2352 x 1568 pixels: 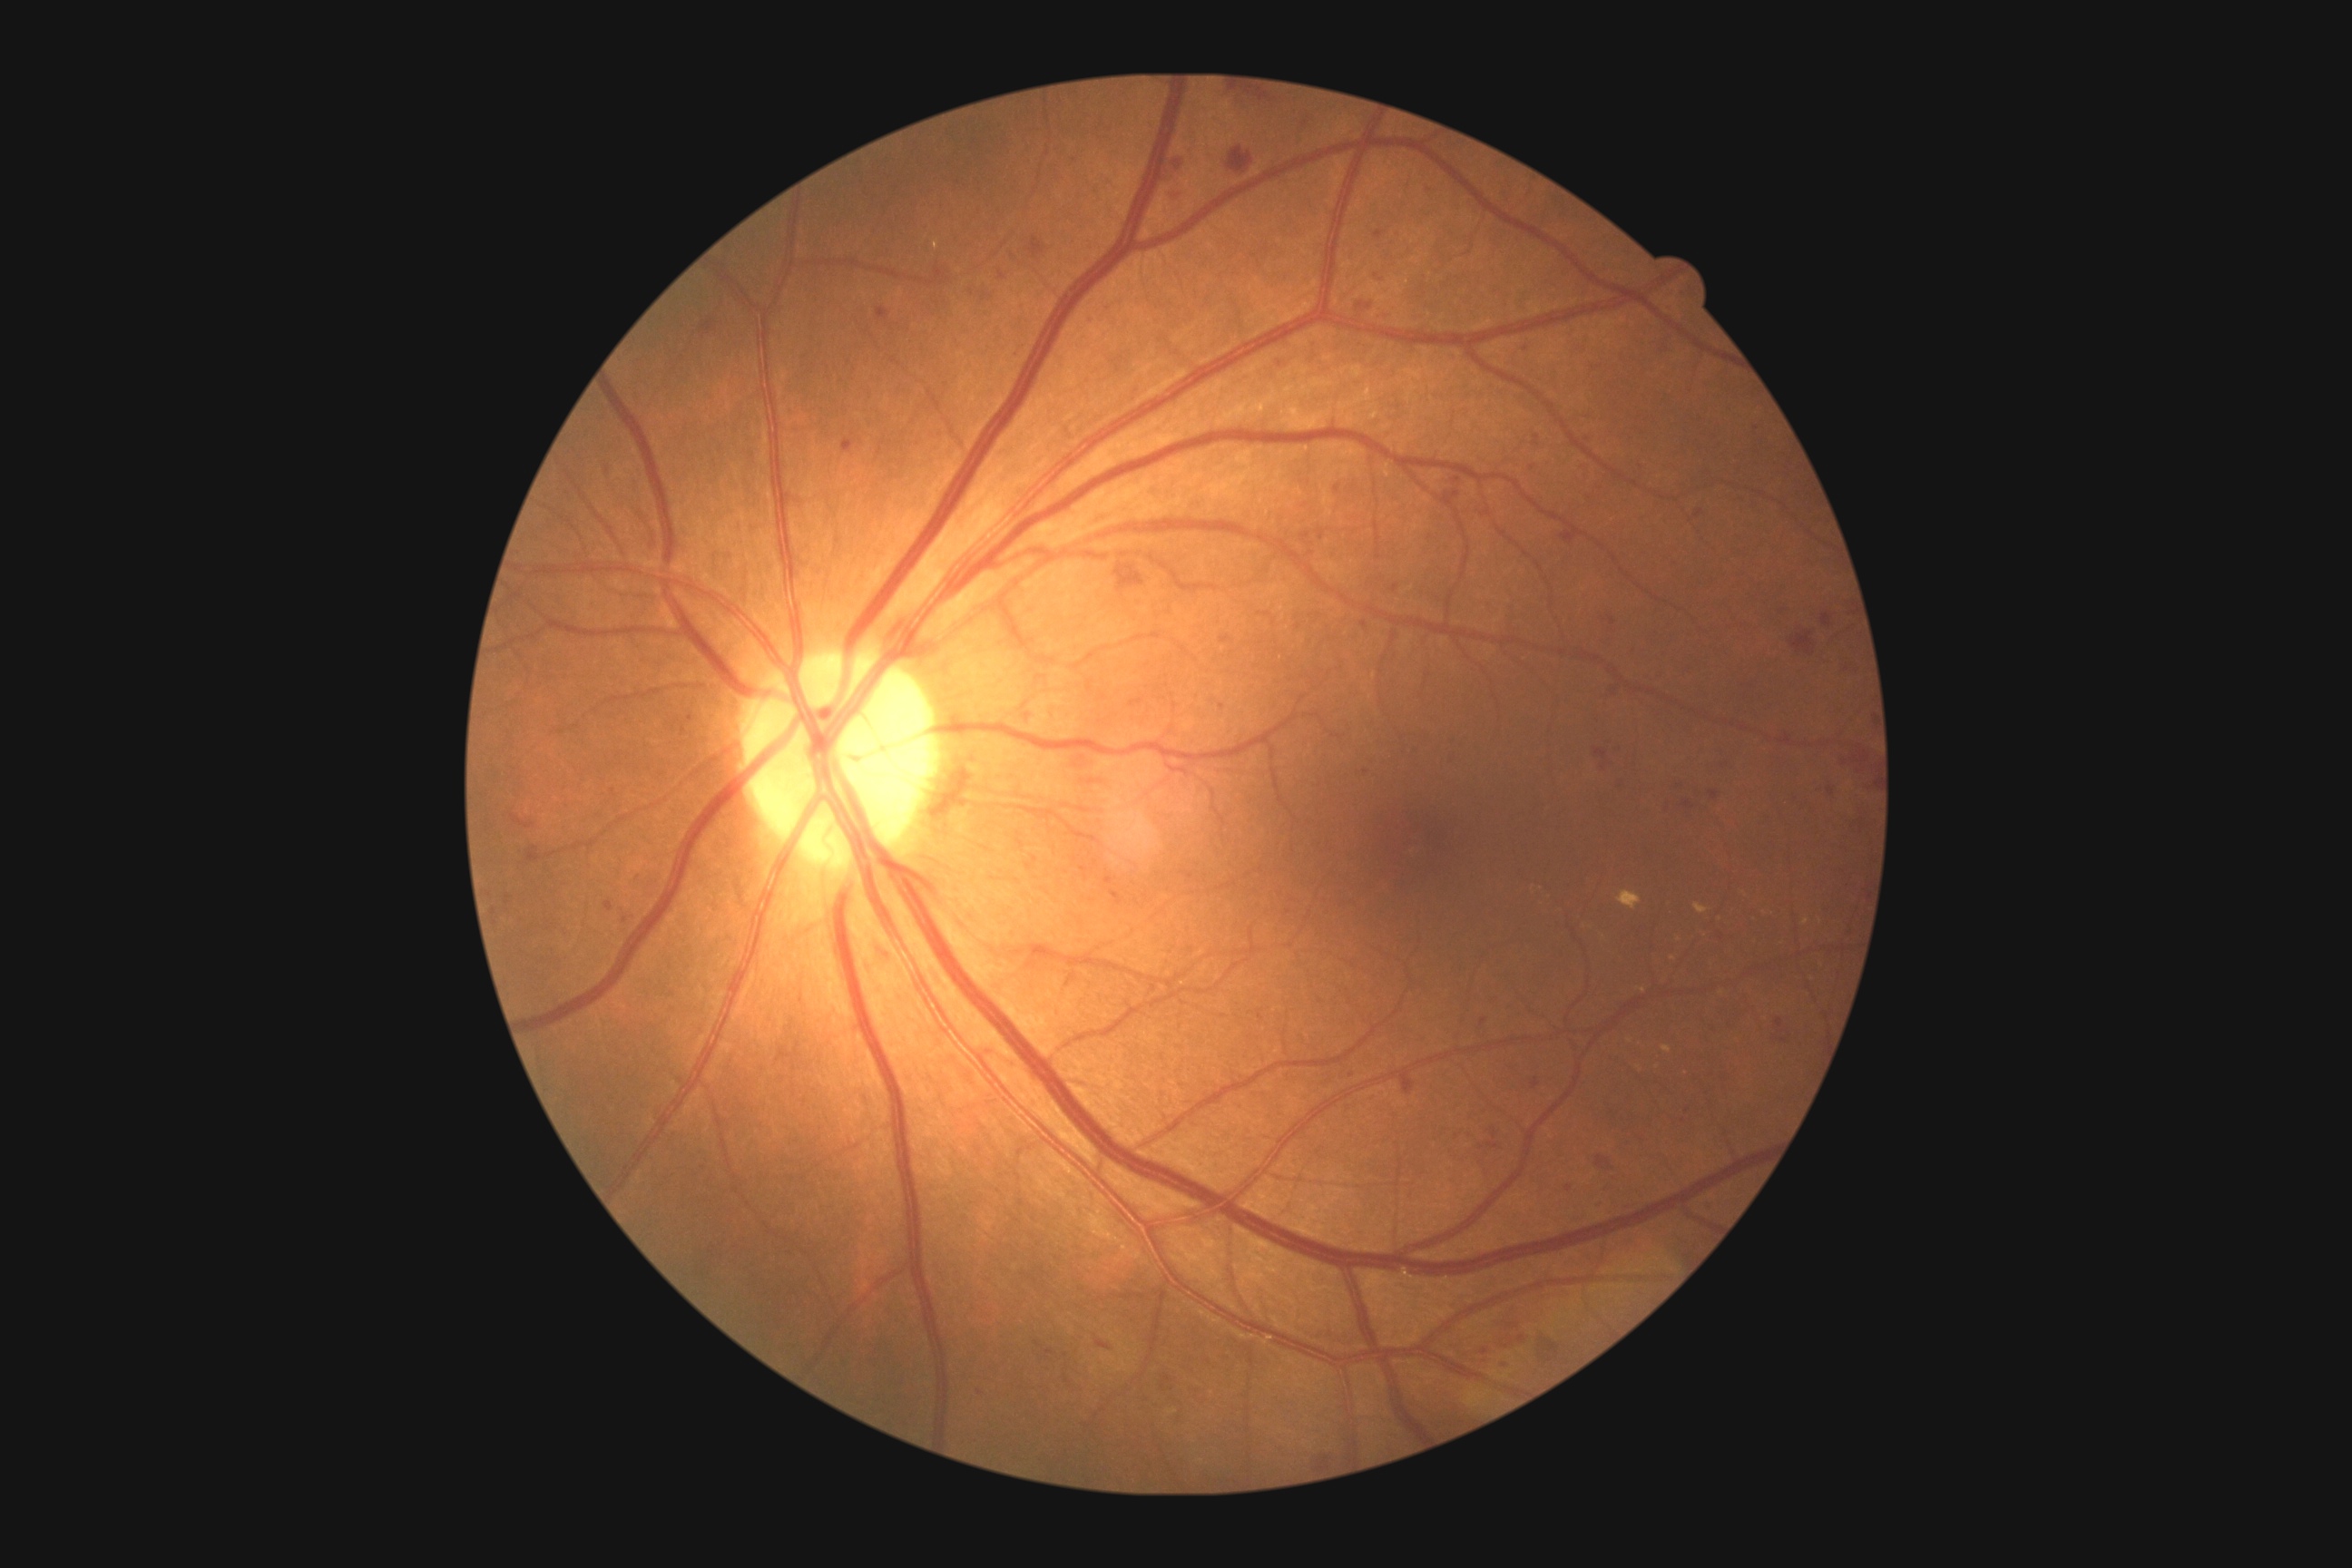
partial: true
dr_grade: 2
dr_grade_name: moderate NPDR
lesions:
  he:
    - bbox=(1828, 789, 1836, 796)
    - bbox=(1097, 1340, 1112, 1351)
    - bbox=(1596, 1202, 1605, 1211)
    - bbox=(1228, 148, 1253, 175)
    - bbox=(876, 308, 890, 320)
    - bbox=(1596, 1155, 1612, 1170)
    - bbox=(1489, 1142, 1498, 1148)
    - bbox=(1373, 304, 1396, 322)
    - bbox=(1527, 464, 1540, 473)
    - bbox=(1157, 1371, 1181, 1396)
    - bbox=(1081, 867, 1090, 881)
    - bbox=(1531, 1079, 1540, 1090)
    - bbox=(1690, 504, 1709, 522)
    - bbox=(1086, 317, 1095, 324)
    - bbox=(1224, 90, 1288, 112)
  he_small:
    - [1776, 1039]
    - [625, 921]
    - [1028, 717]
    - [1221, 707]
    - [1034, 859]